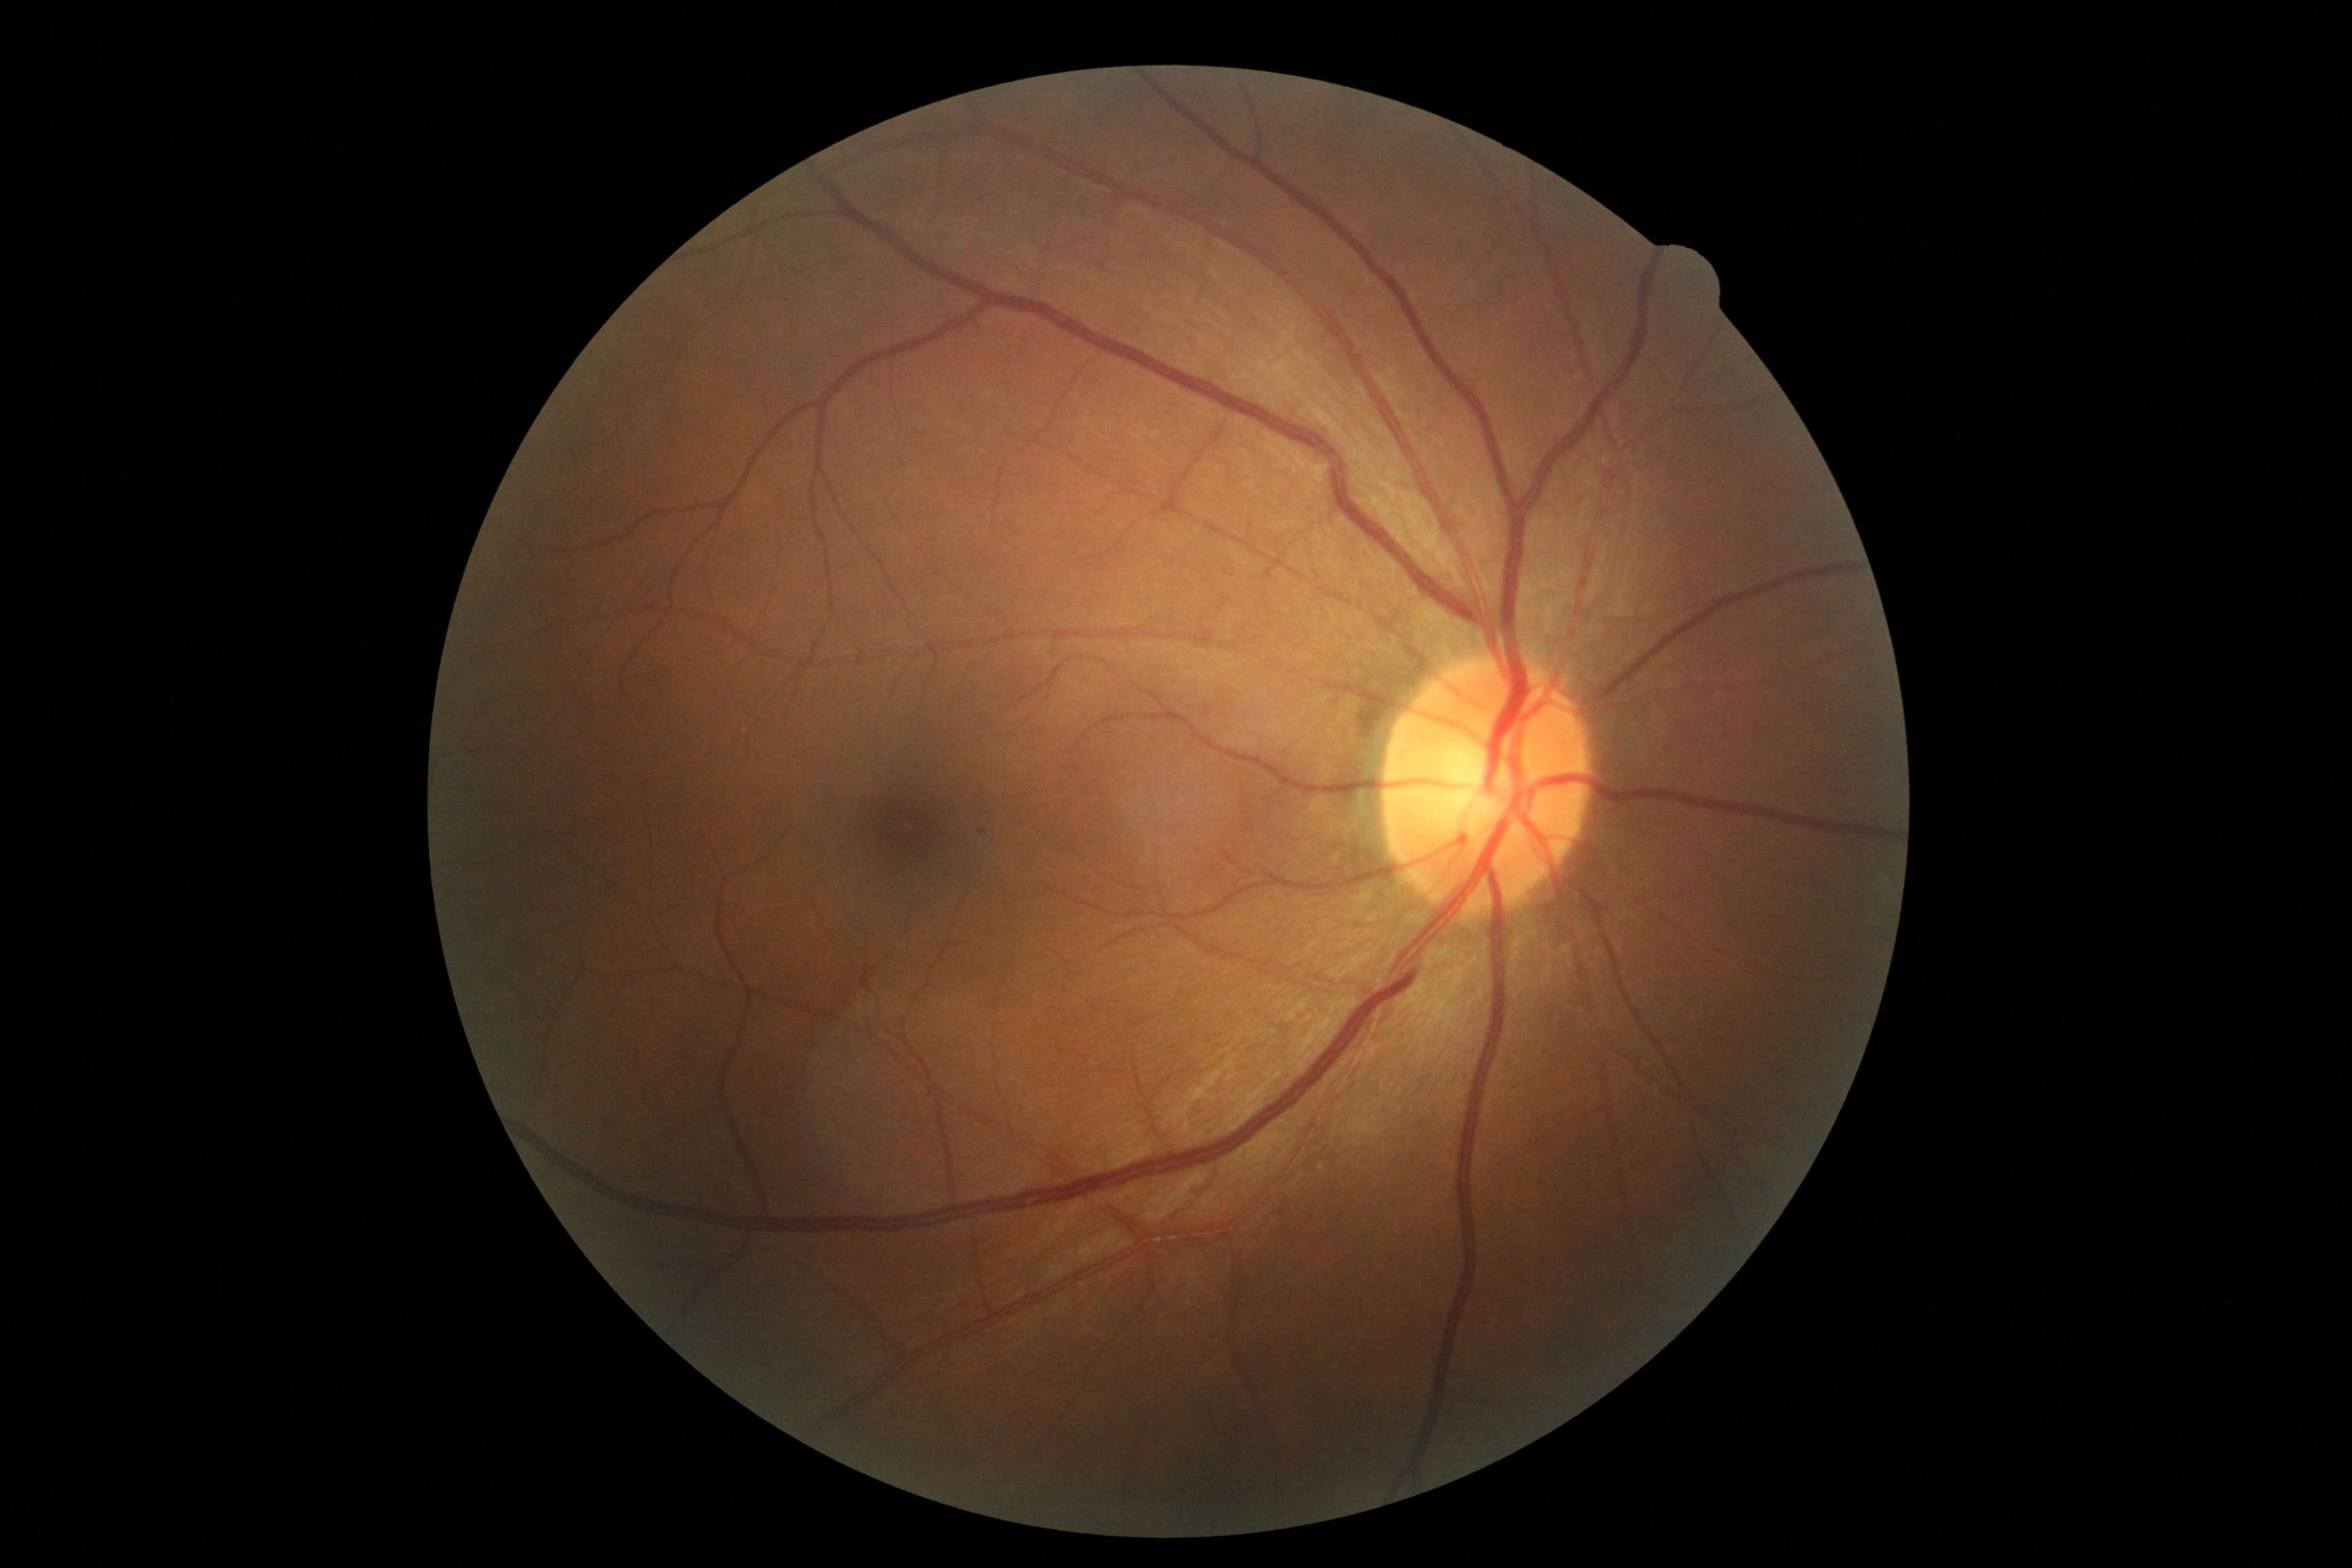

DR grade is 1 (mild NPDR). DR class: non-proliferative diabetic retinopathy.